2352x1568.
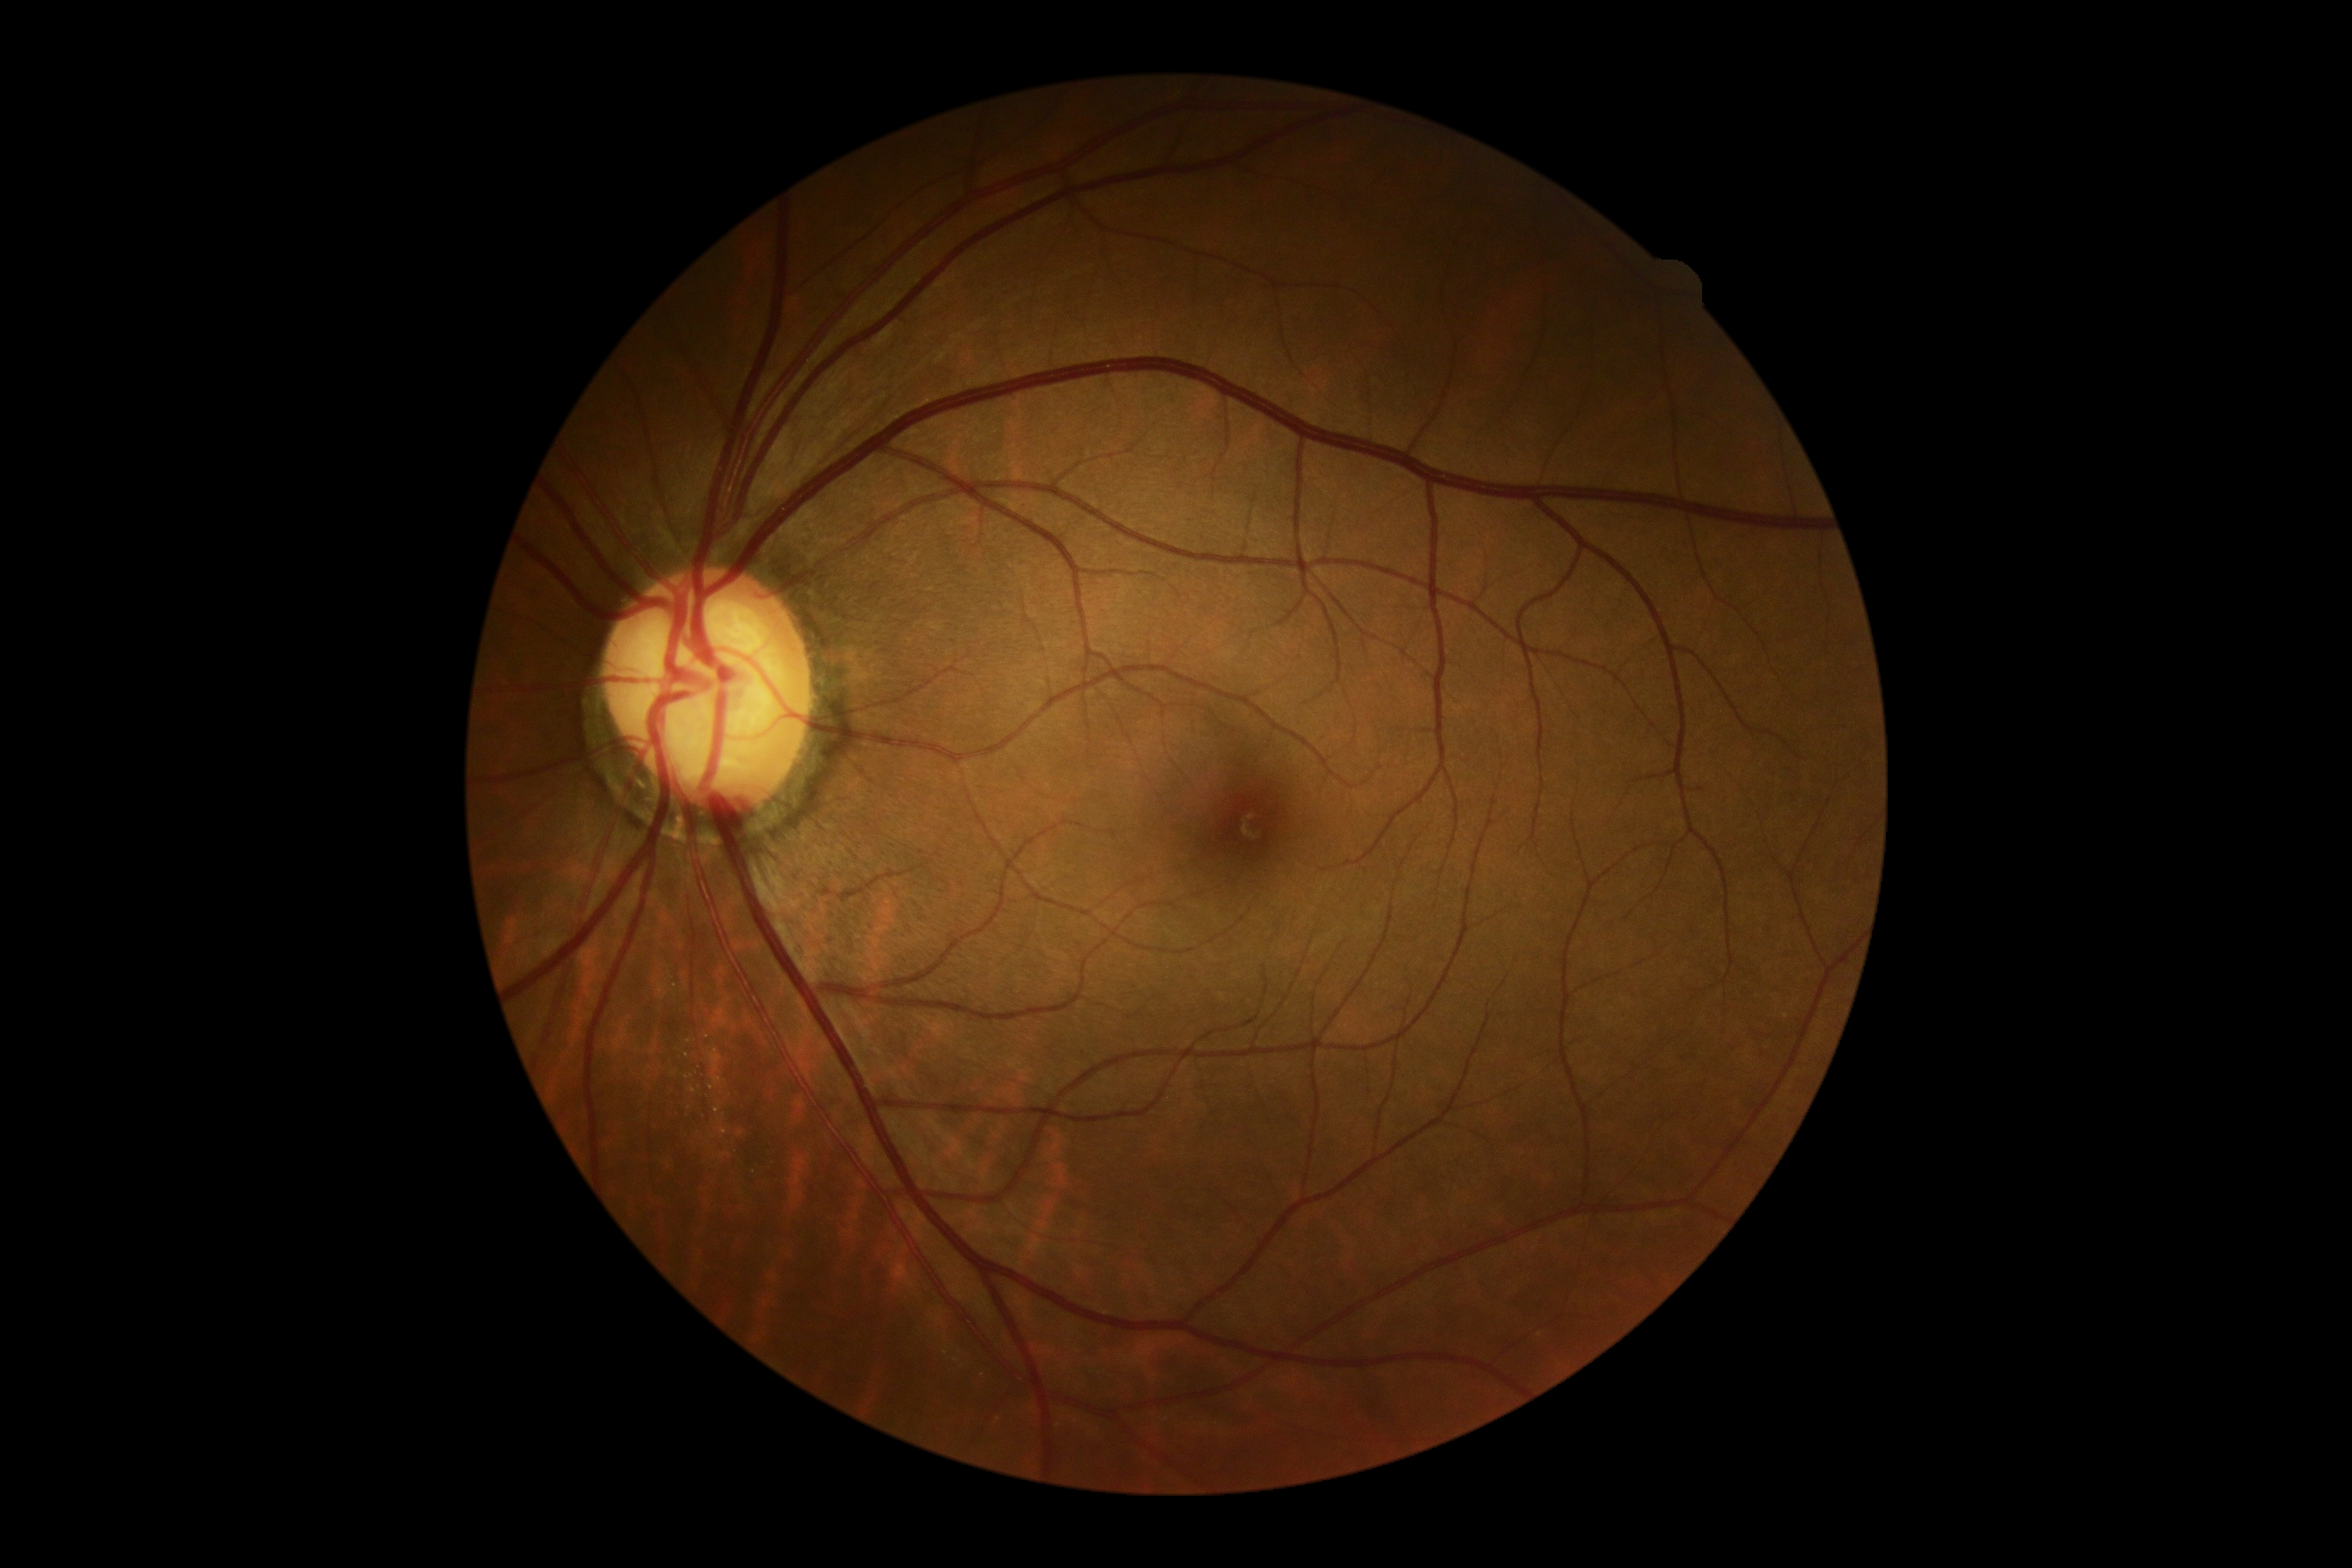 DR: 0/4 — no visible signs of diabetic retinopathy.